Natus RetCam Envision, 130° FOV. Wide-field fundus photograph of an infant
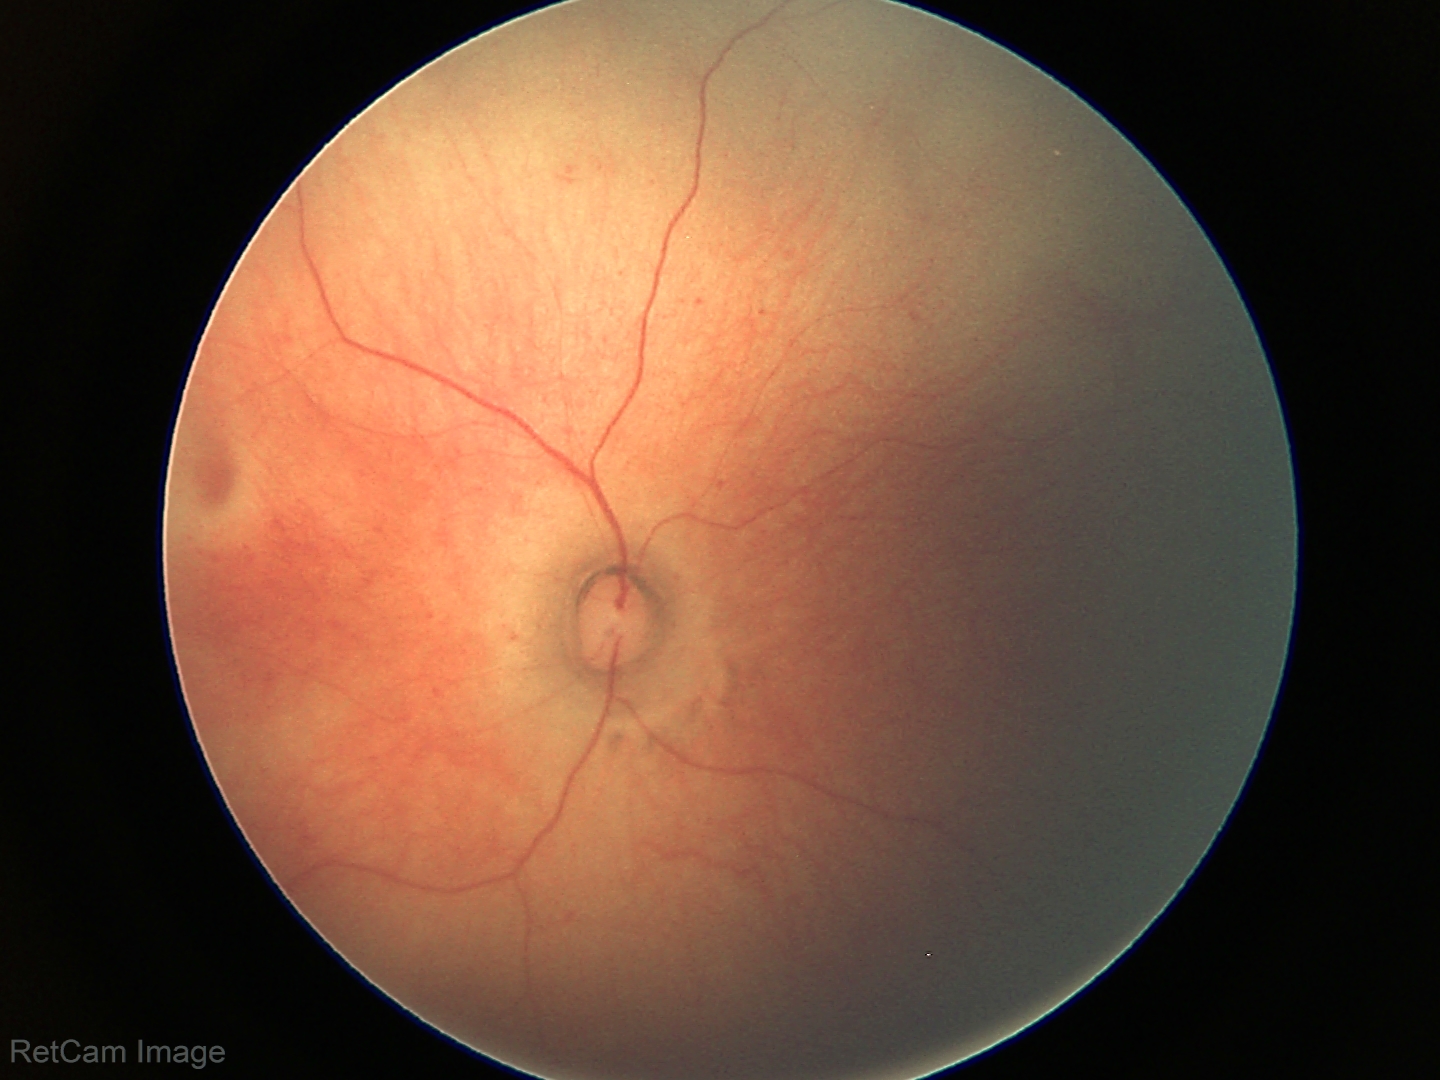 Screening examination diagnosed as physiological.